50° field of view.
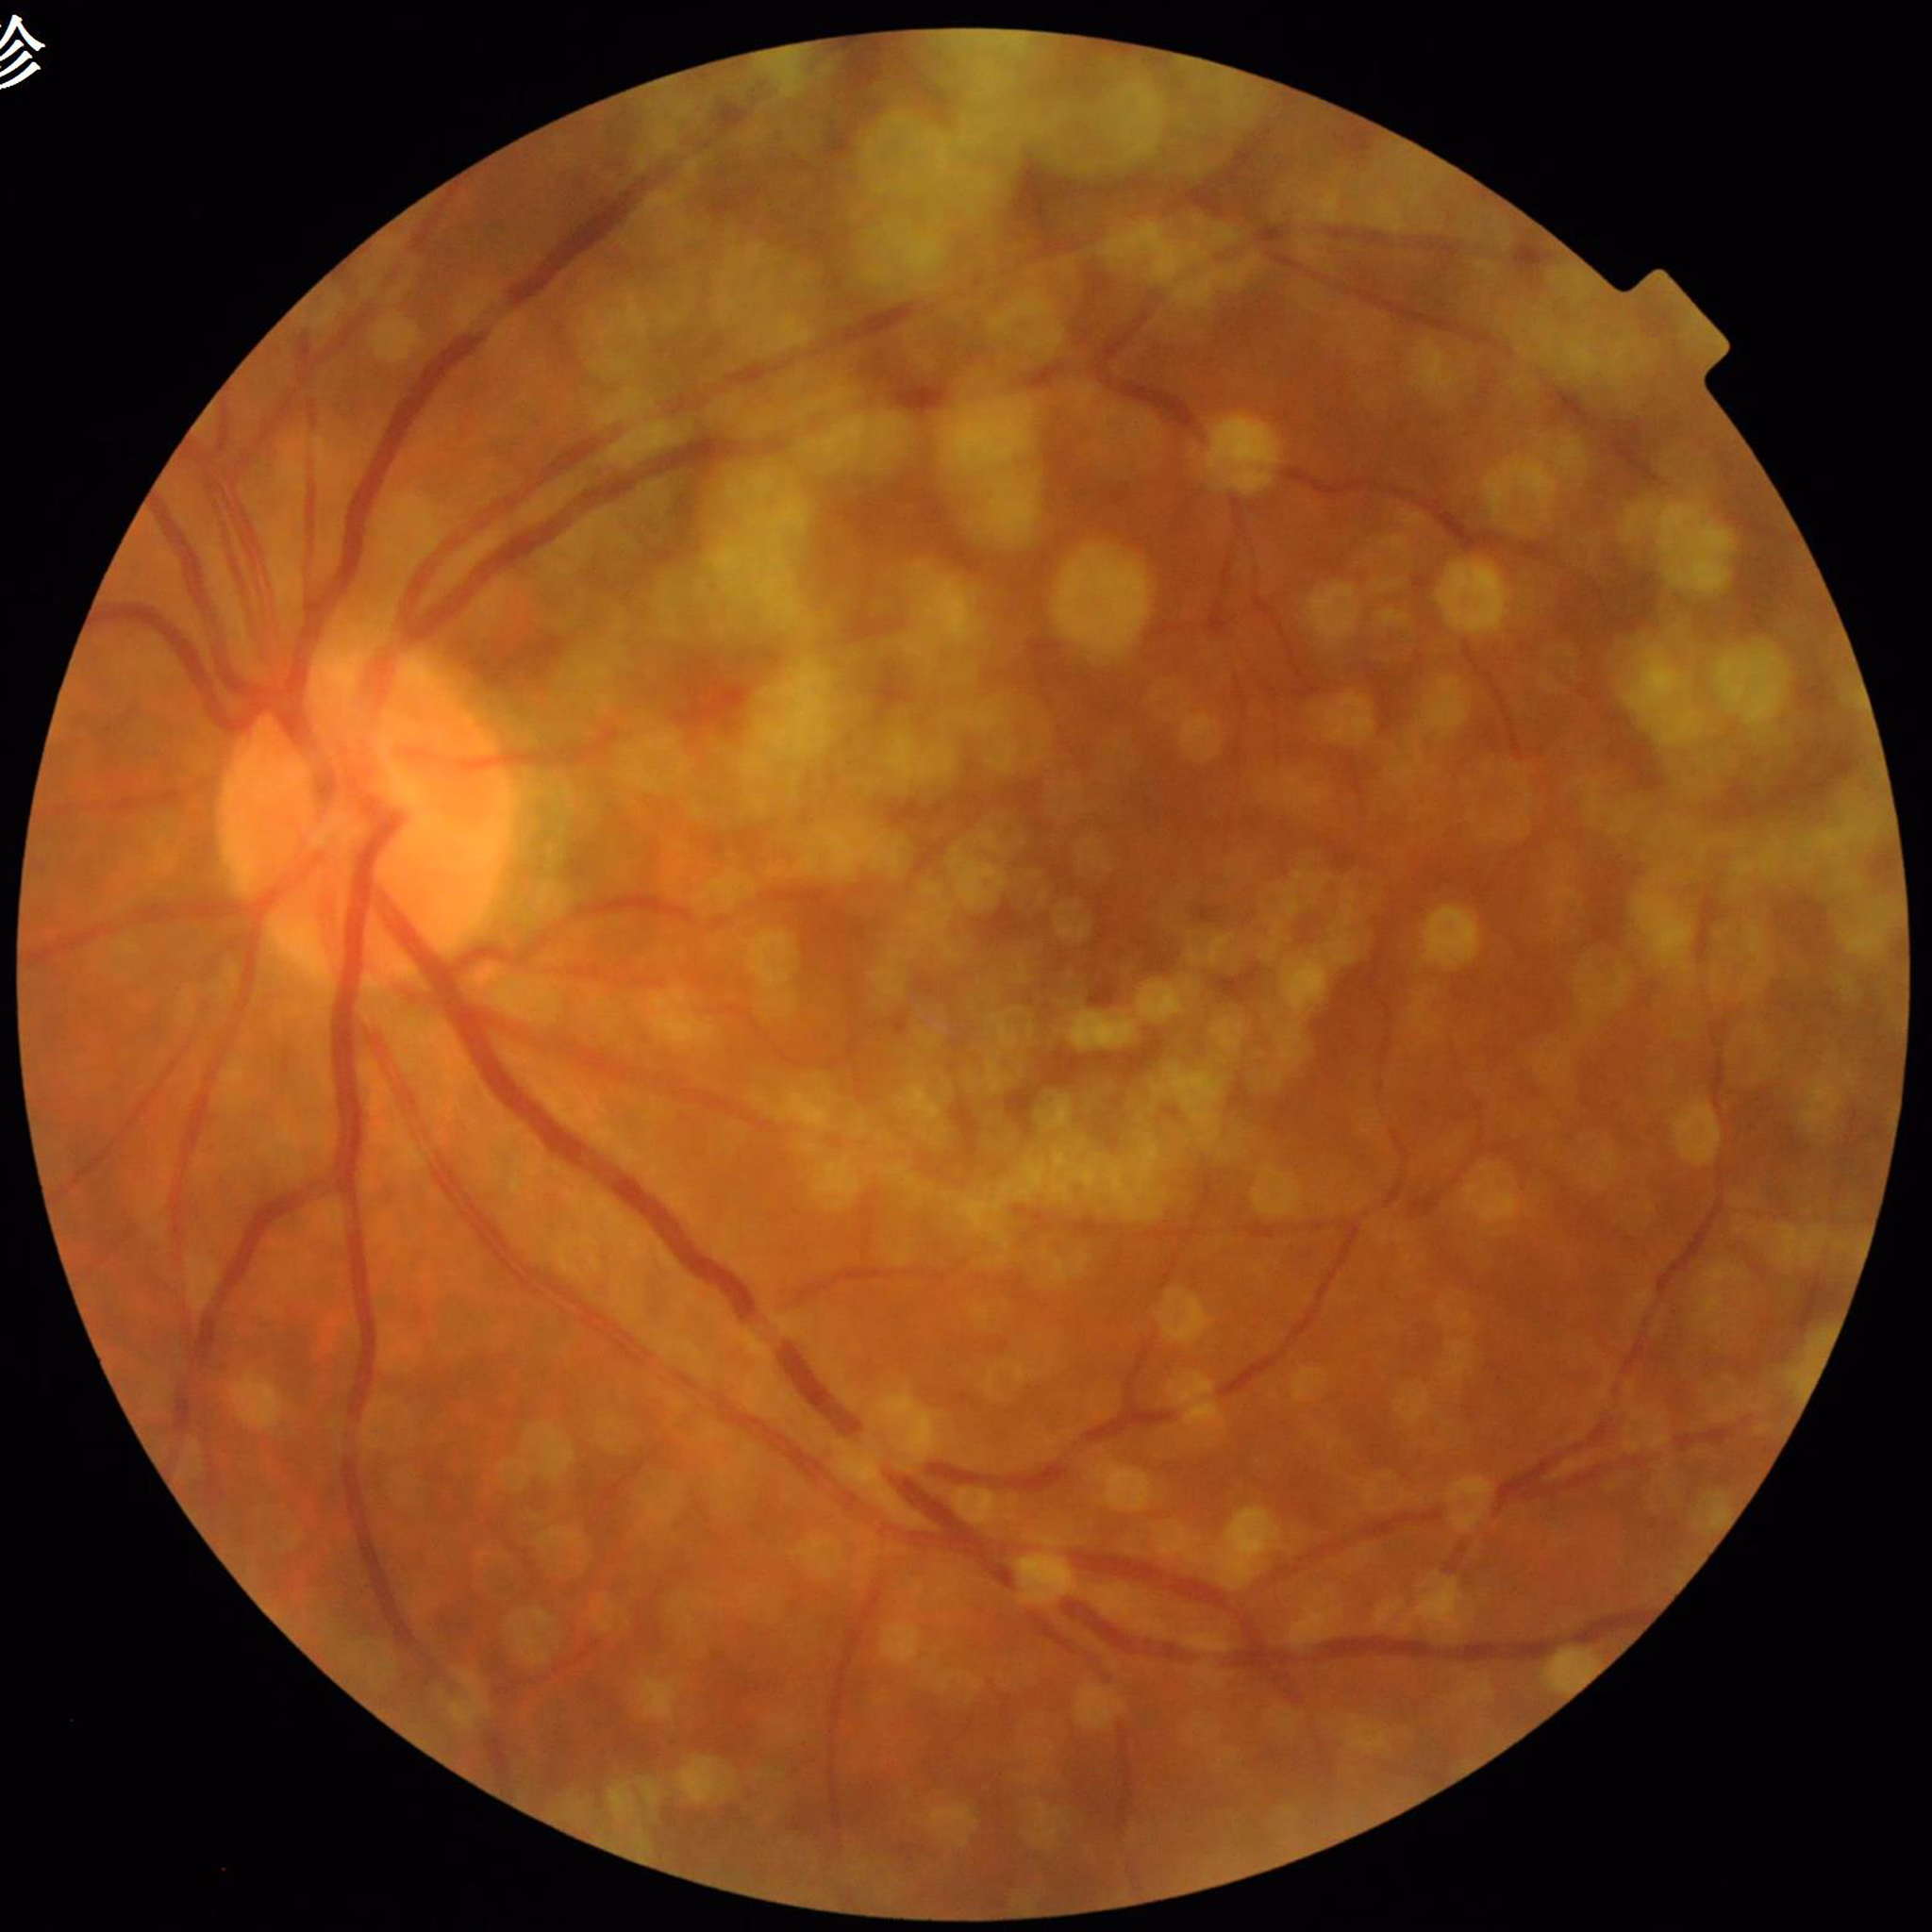
Disease: AMD